Camera: Nidek AFC-330: 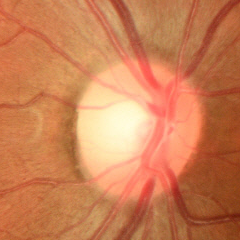
Q: Is glaucoma present?
A: No — no evidence of glaucoma.